Remidio Fundus on Phone (FOP) camera; fundus photo — 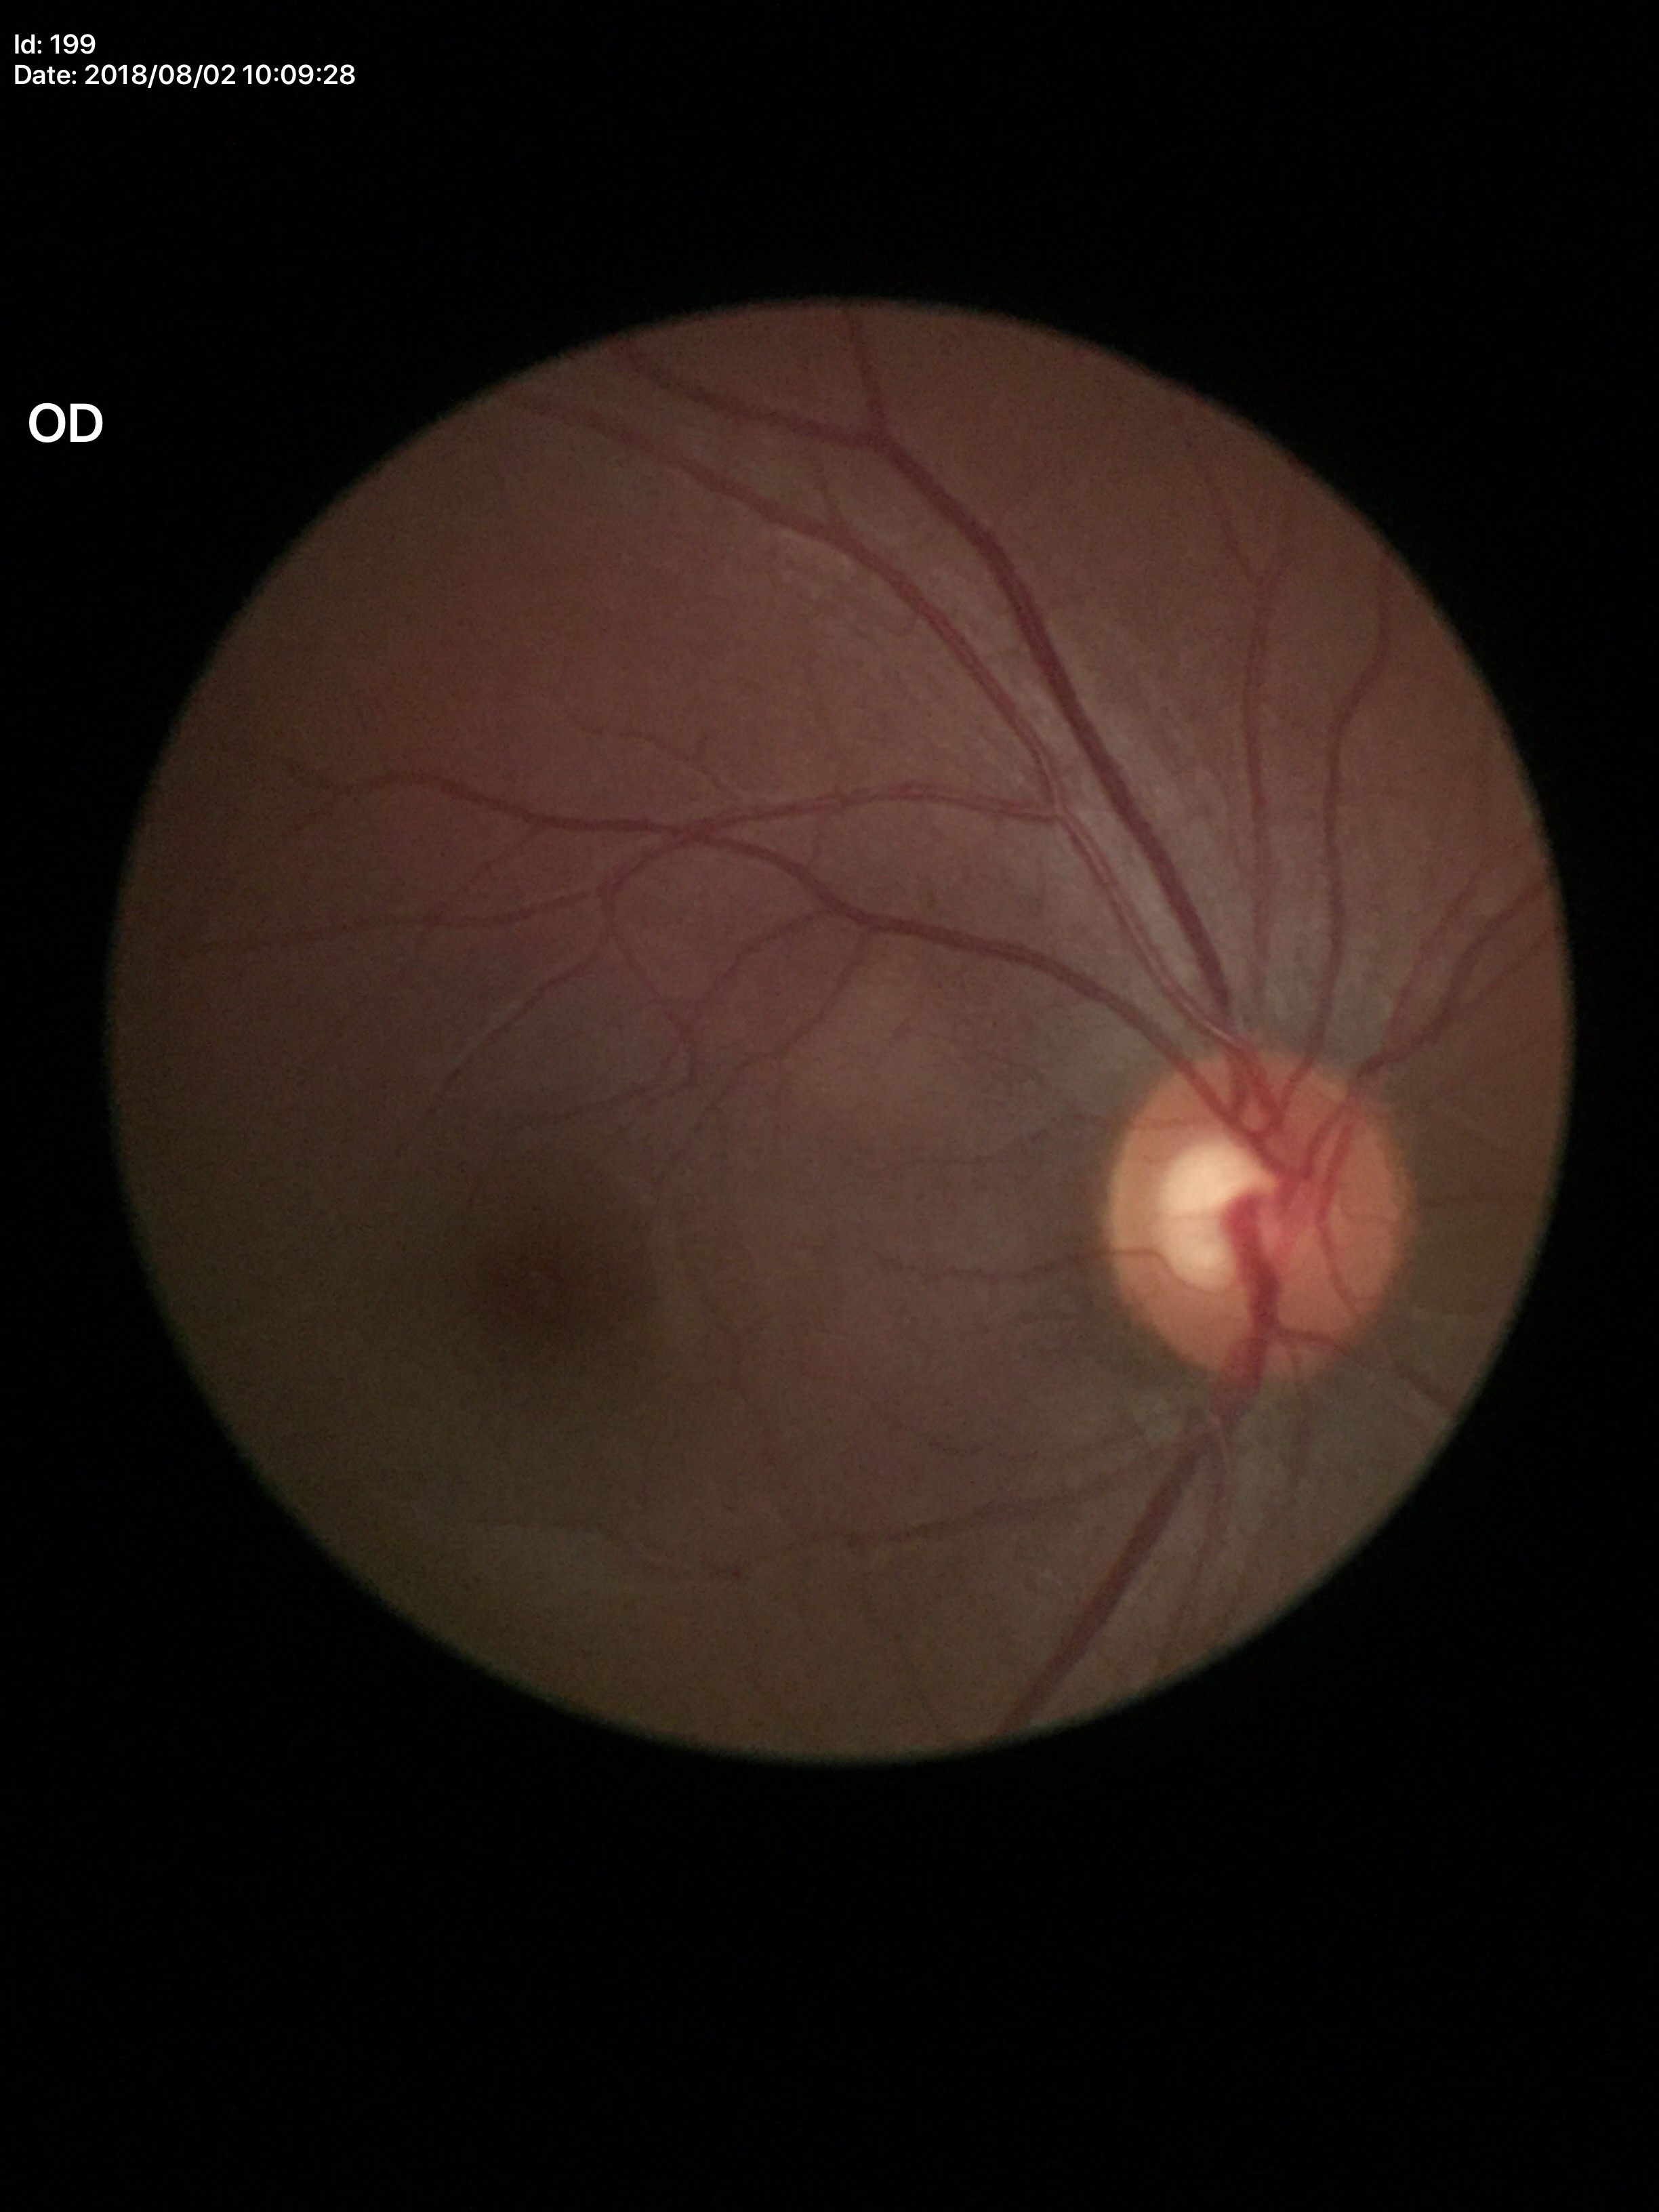 Not suspicious for glaucoma.
Vertical cup-disc ratio (VCDR) of 0.54.
Horizontal cup-to-disc ratio (HCDR) is 0.58.
Area cup-to-disc ratio (ACDR) is 0.32.